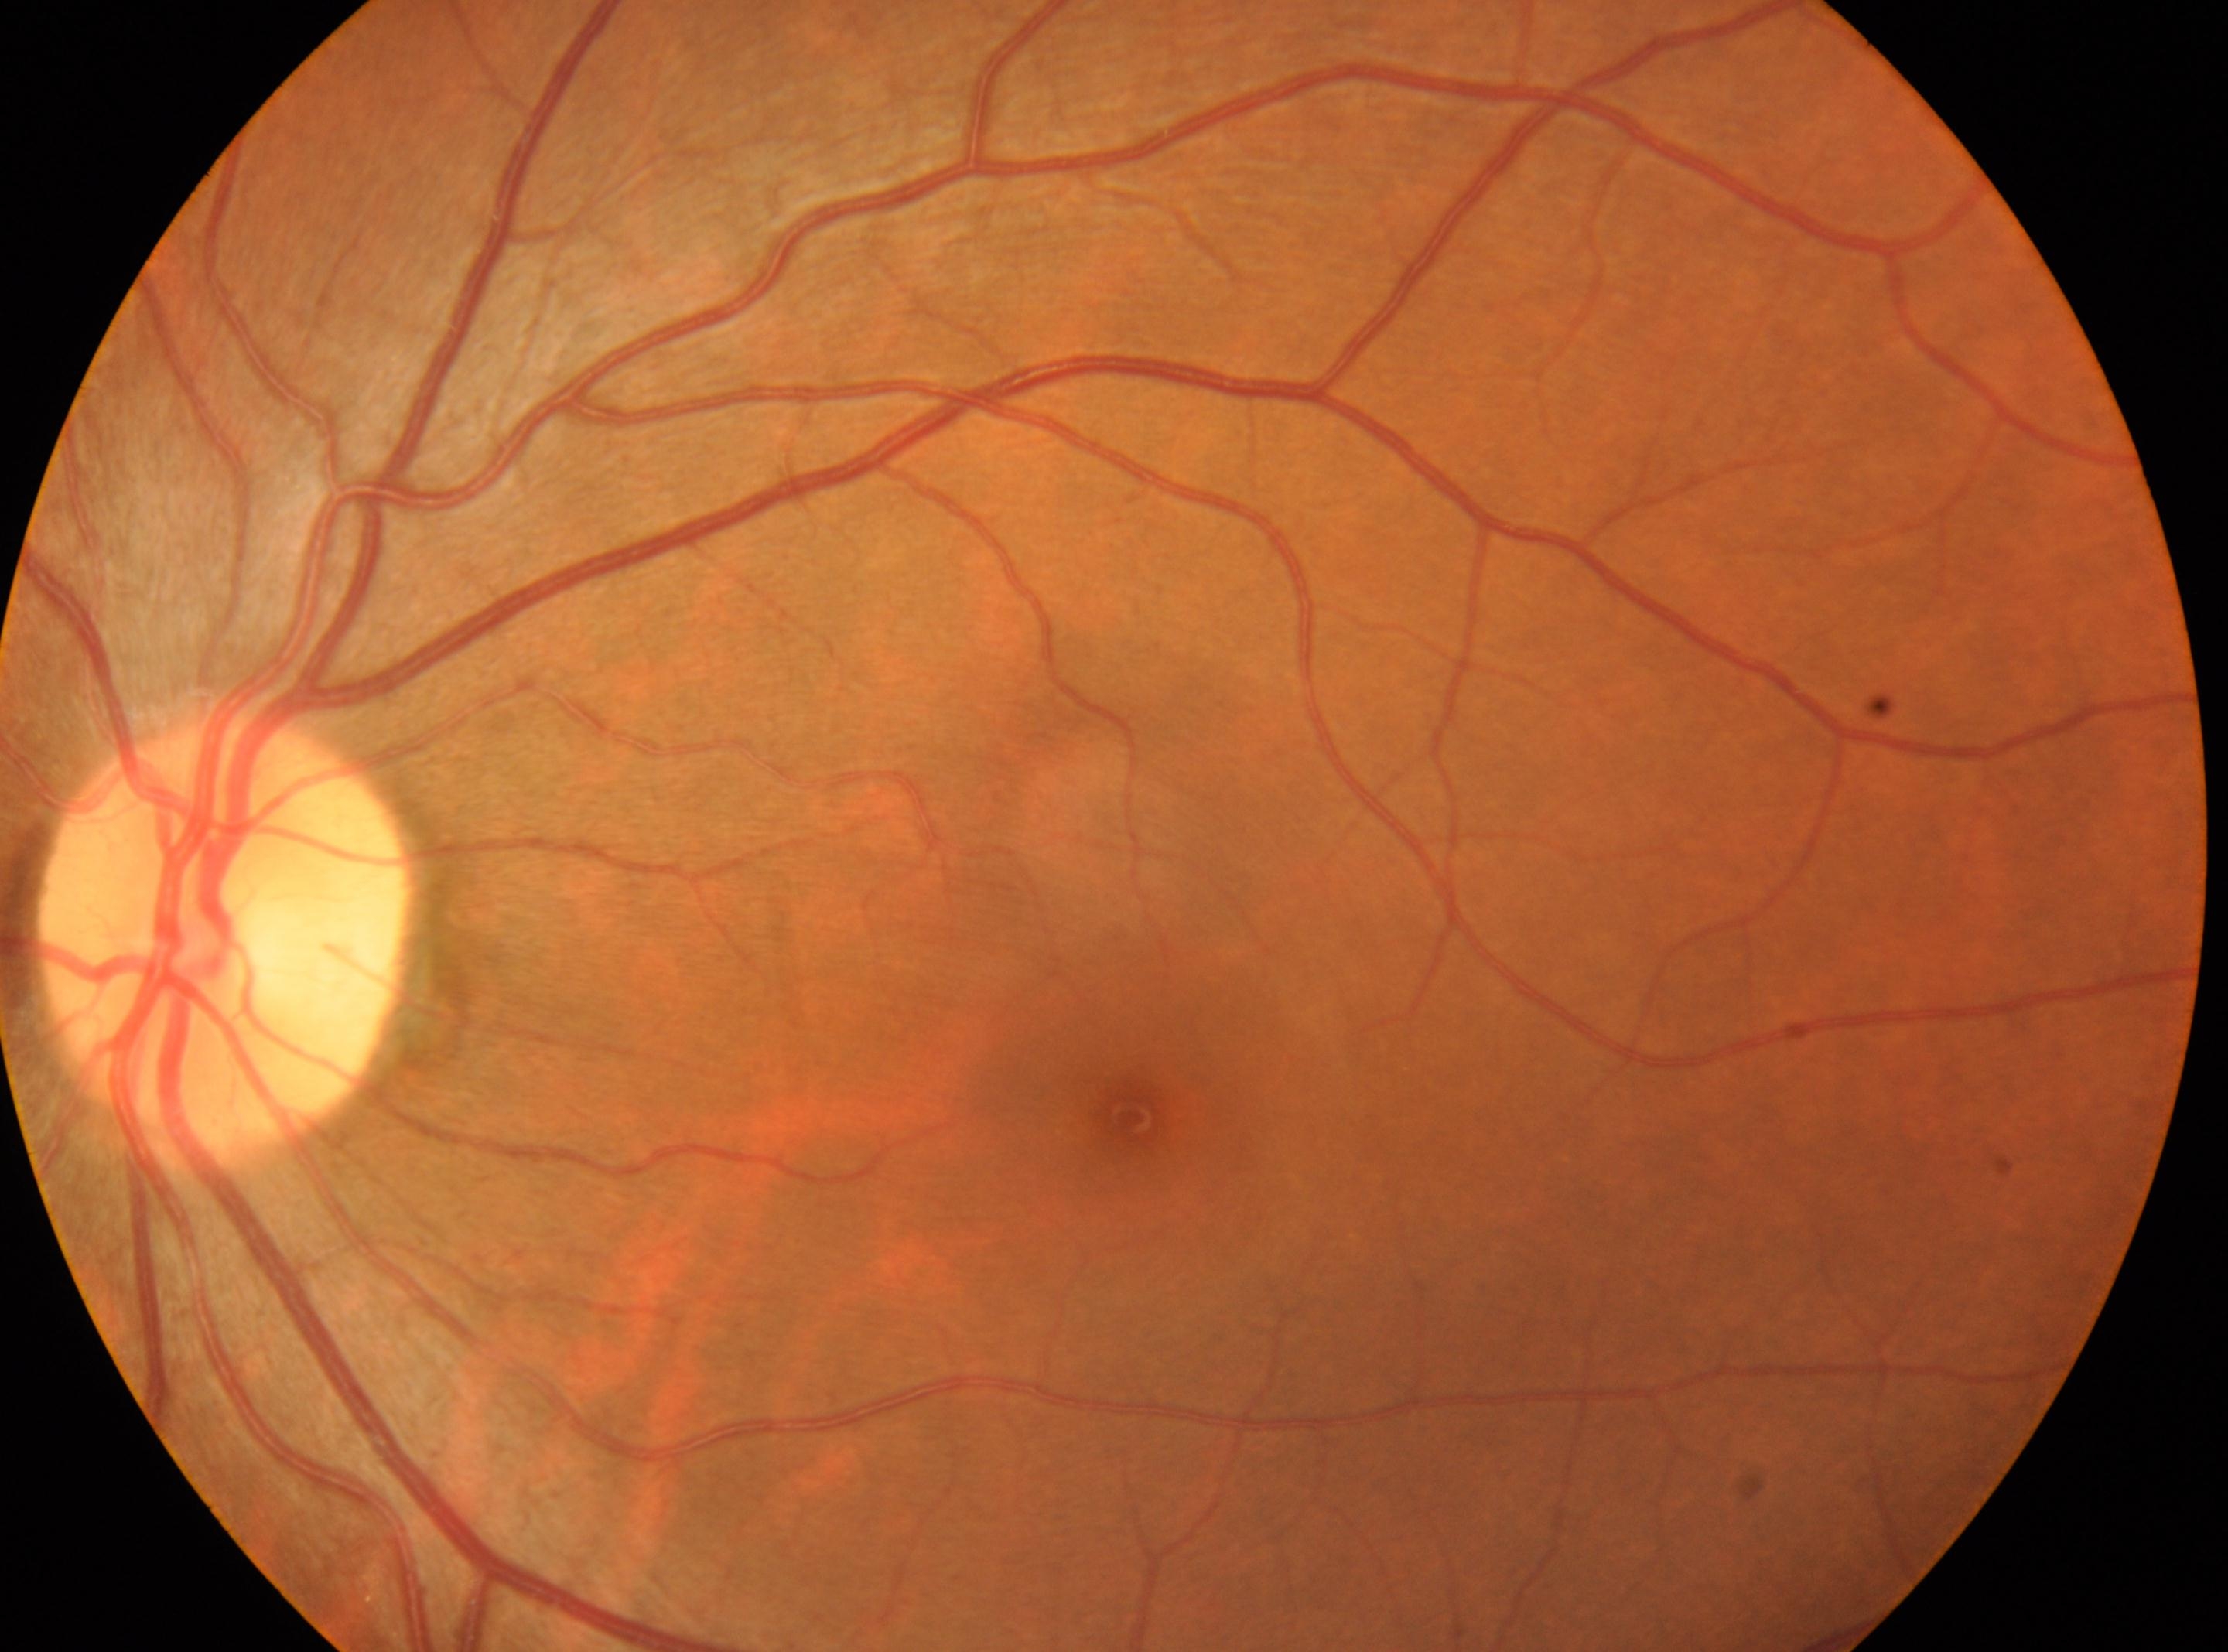
- laterality — the left eye
- DR impression — No diabetic retinopathy identified
- optic disc — 227, 943
- fovea centralis — 1129, 1115
- DR grade — no apparent diabetic retinopathy (0)